Image size 2352x1568; 45° FOV — 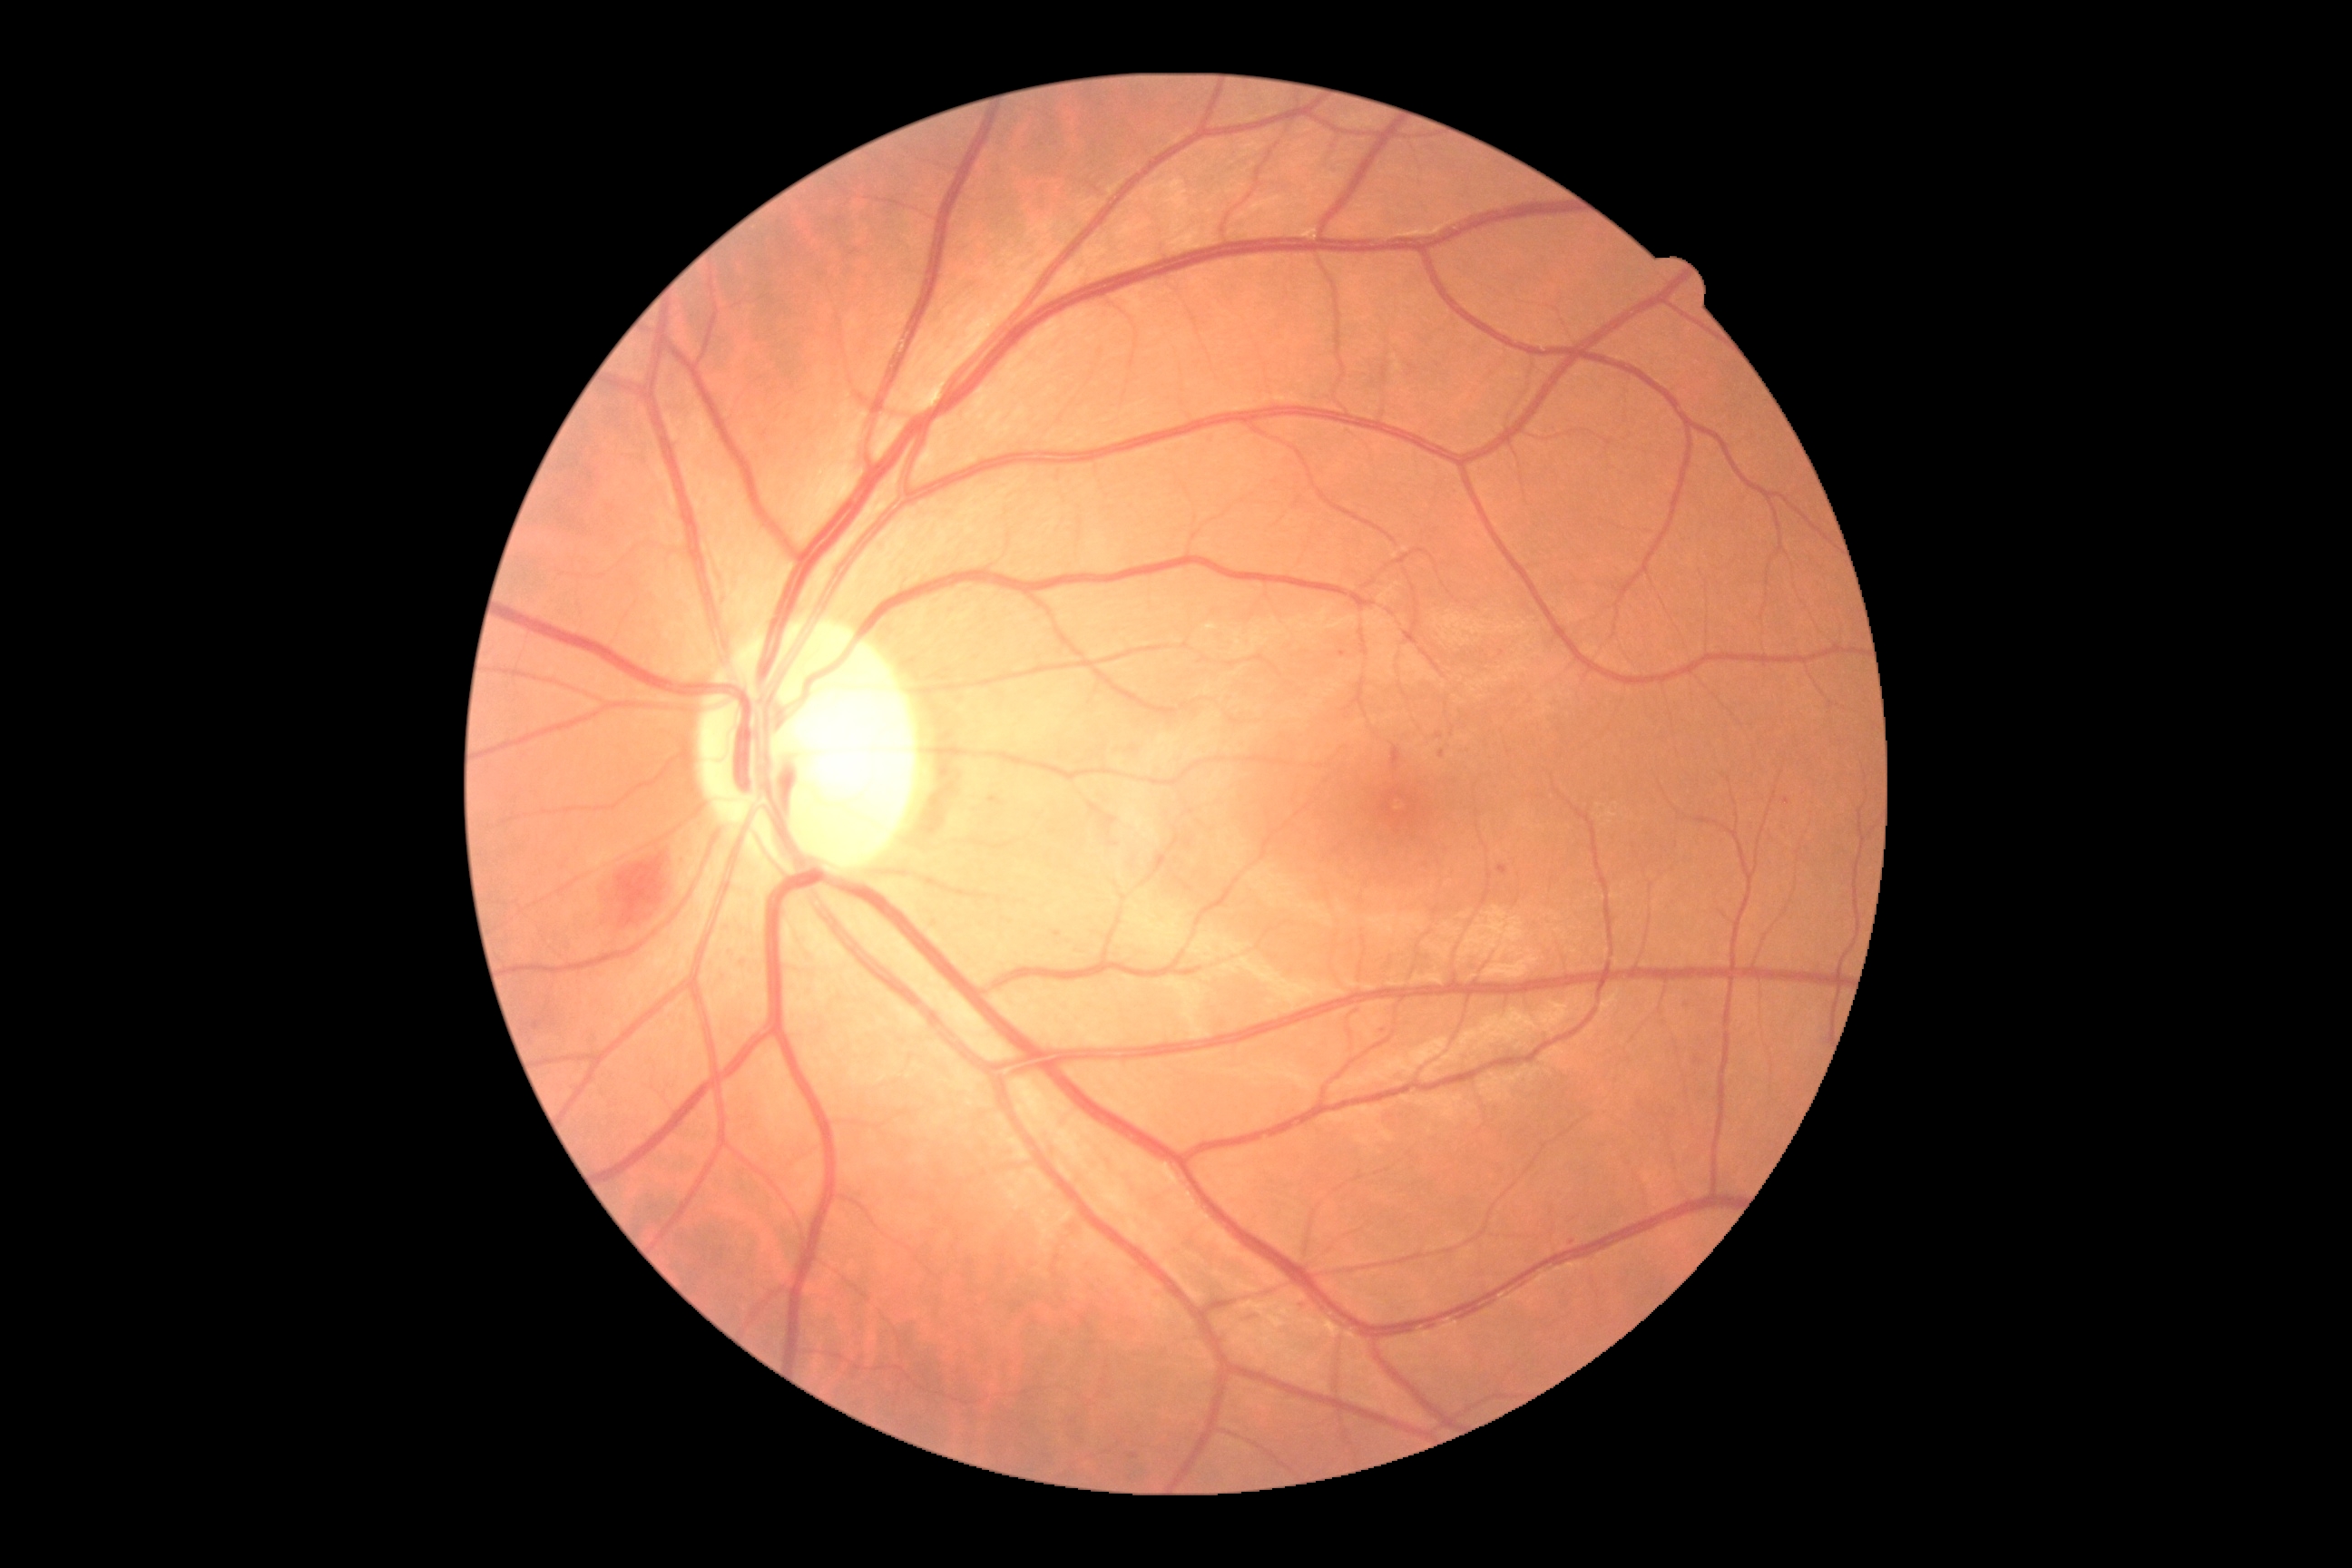

DR grade is moderate non-proliferative diabetic retinopathy (2) — more than just microaneurysms but less than severe NPDR.